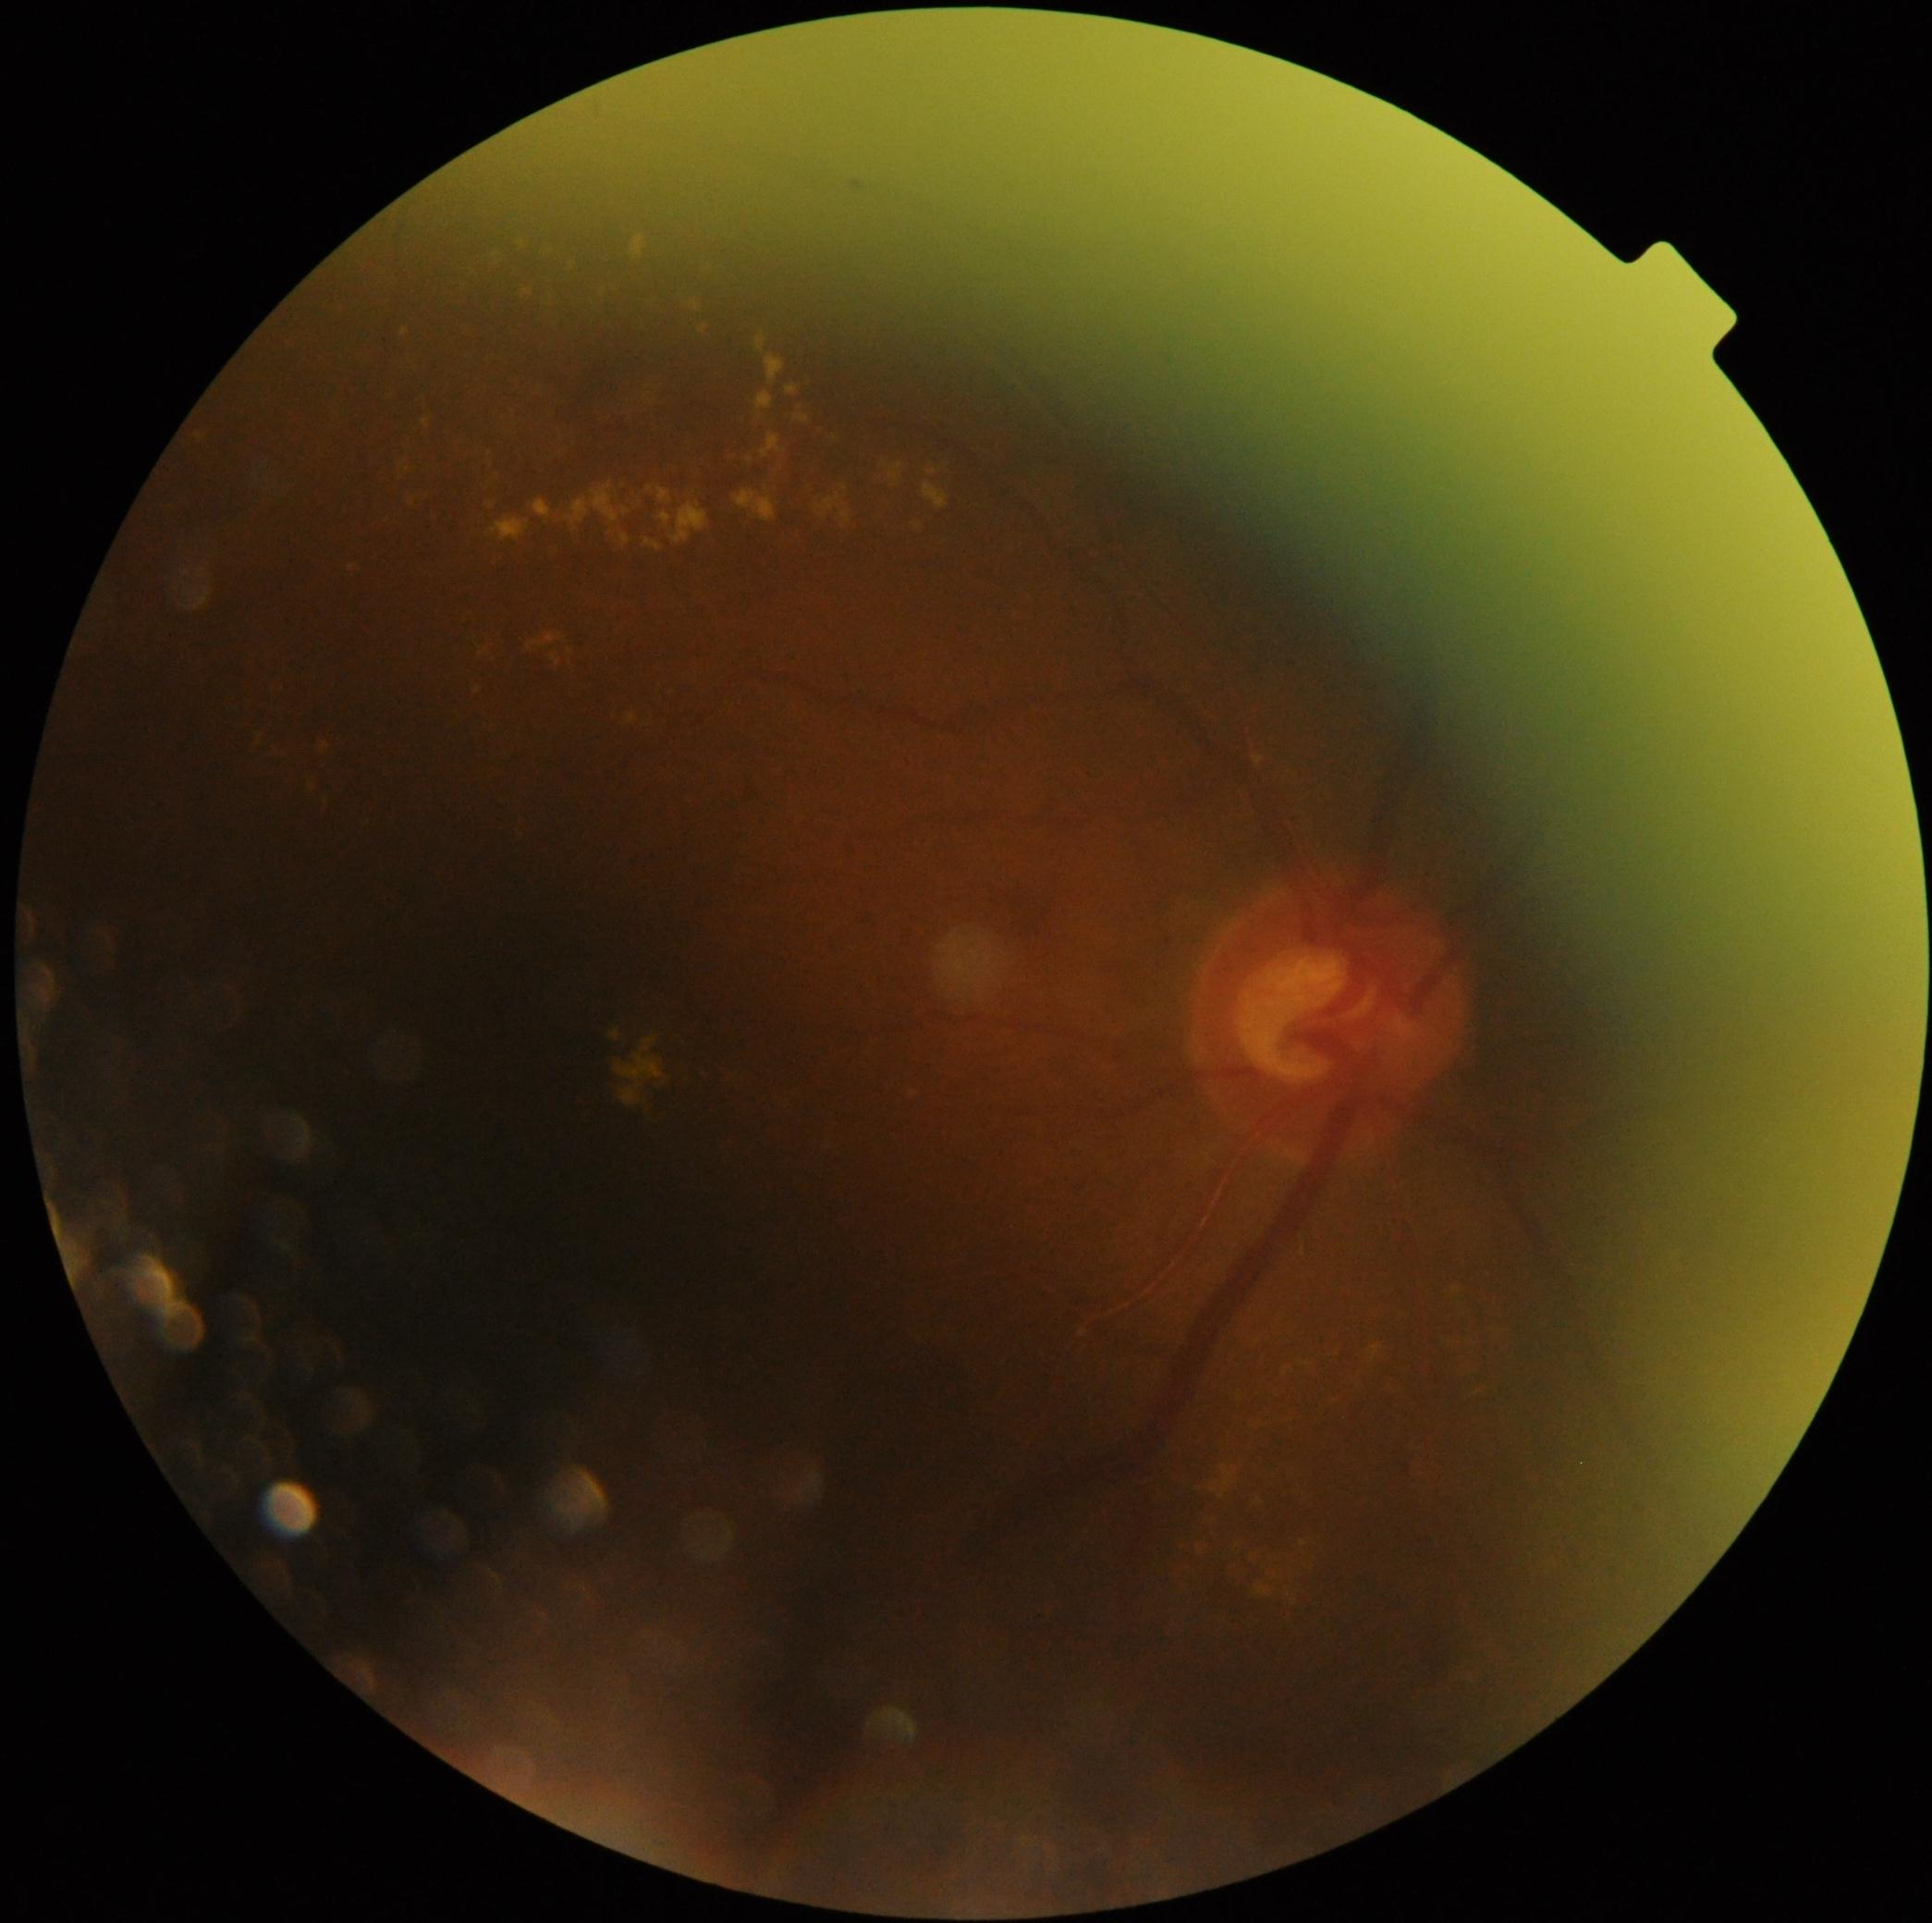

diabetic retinopathy (DR)=grade 2 (moderate NPDR).